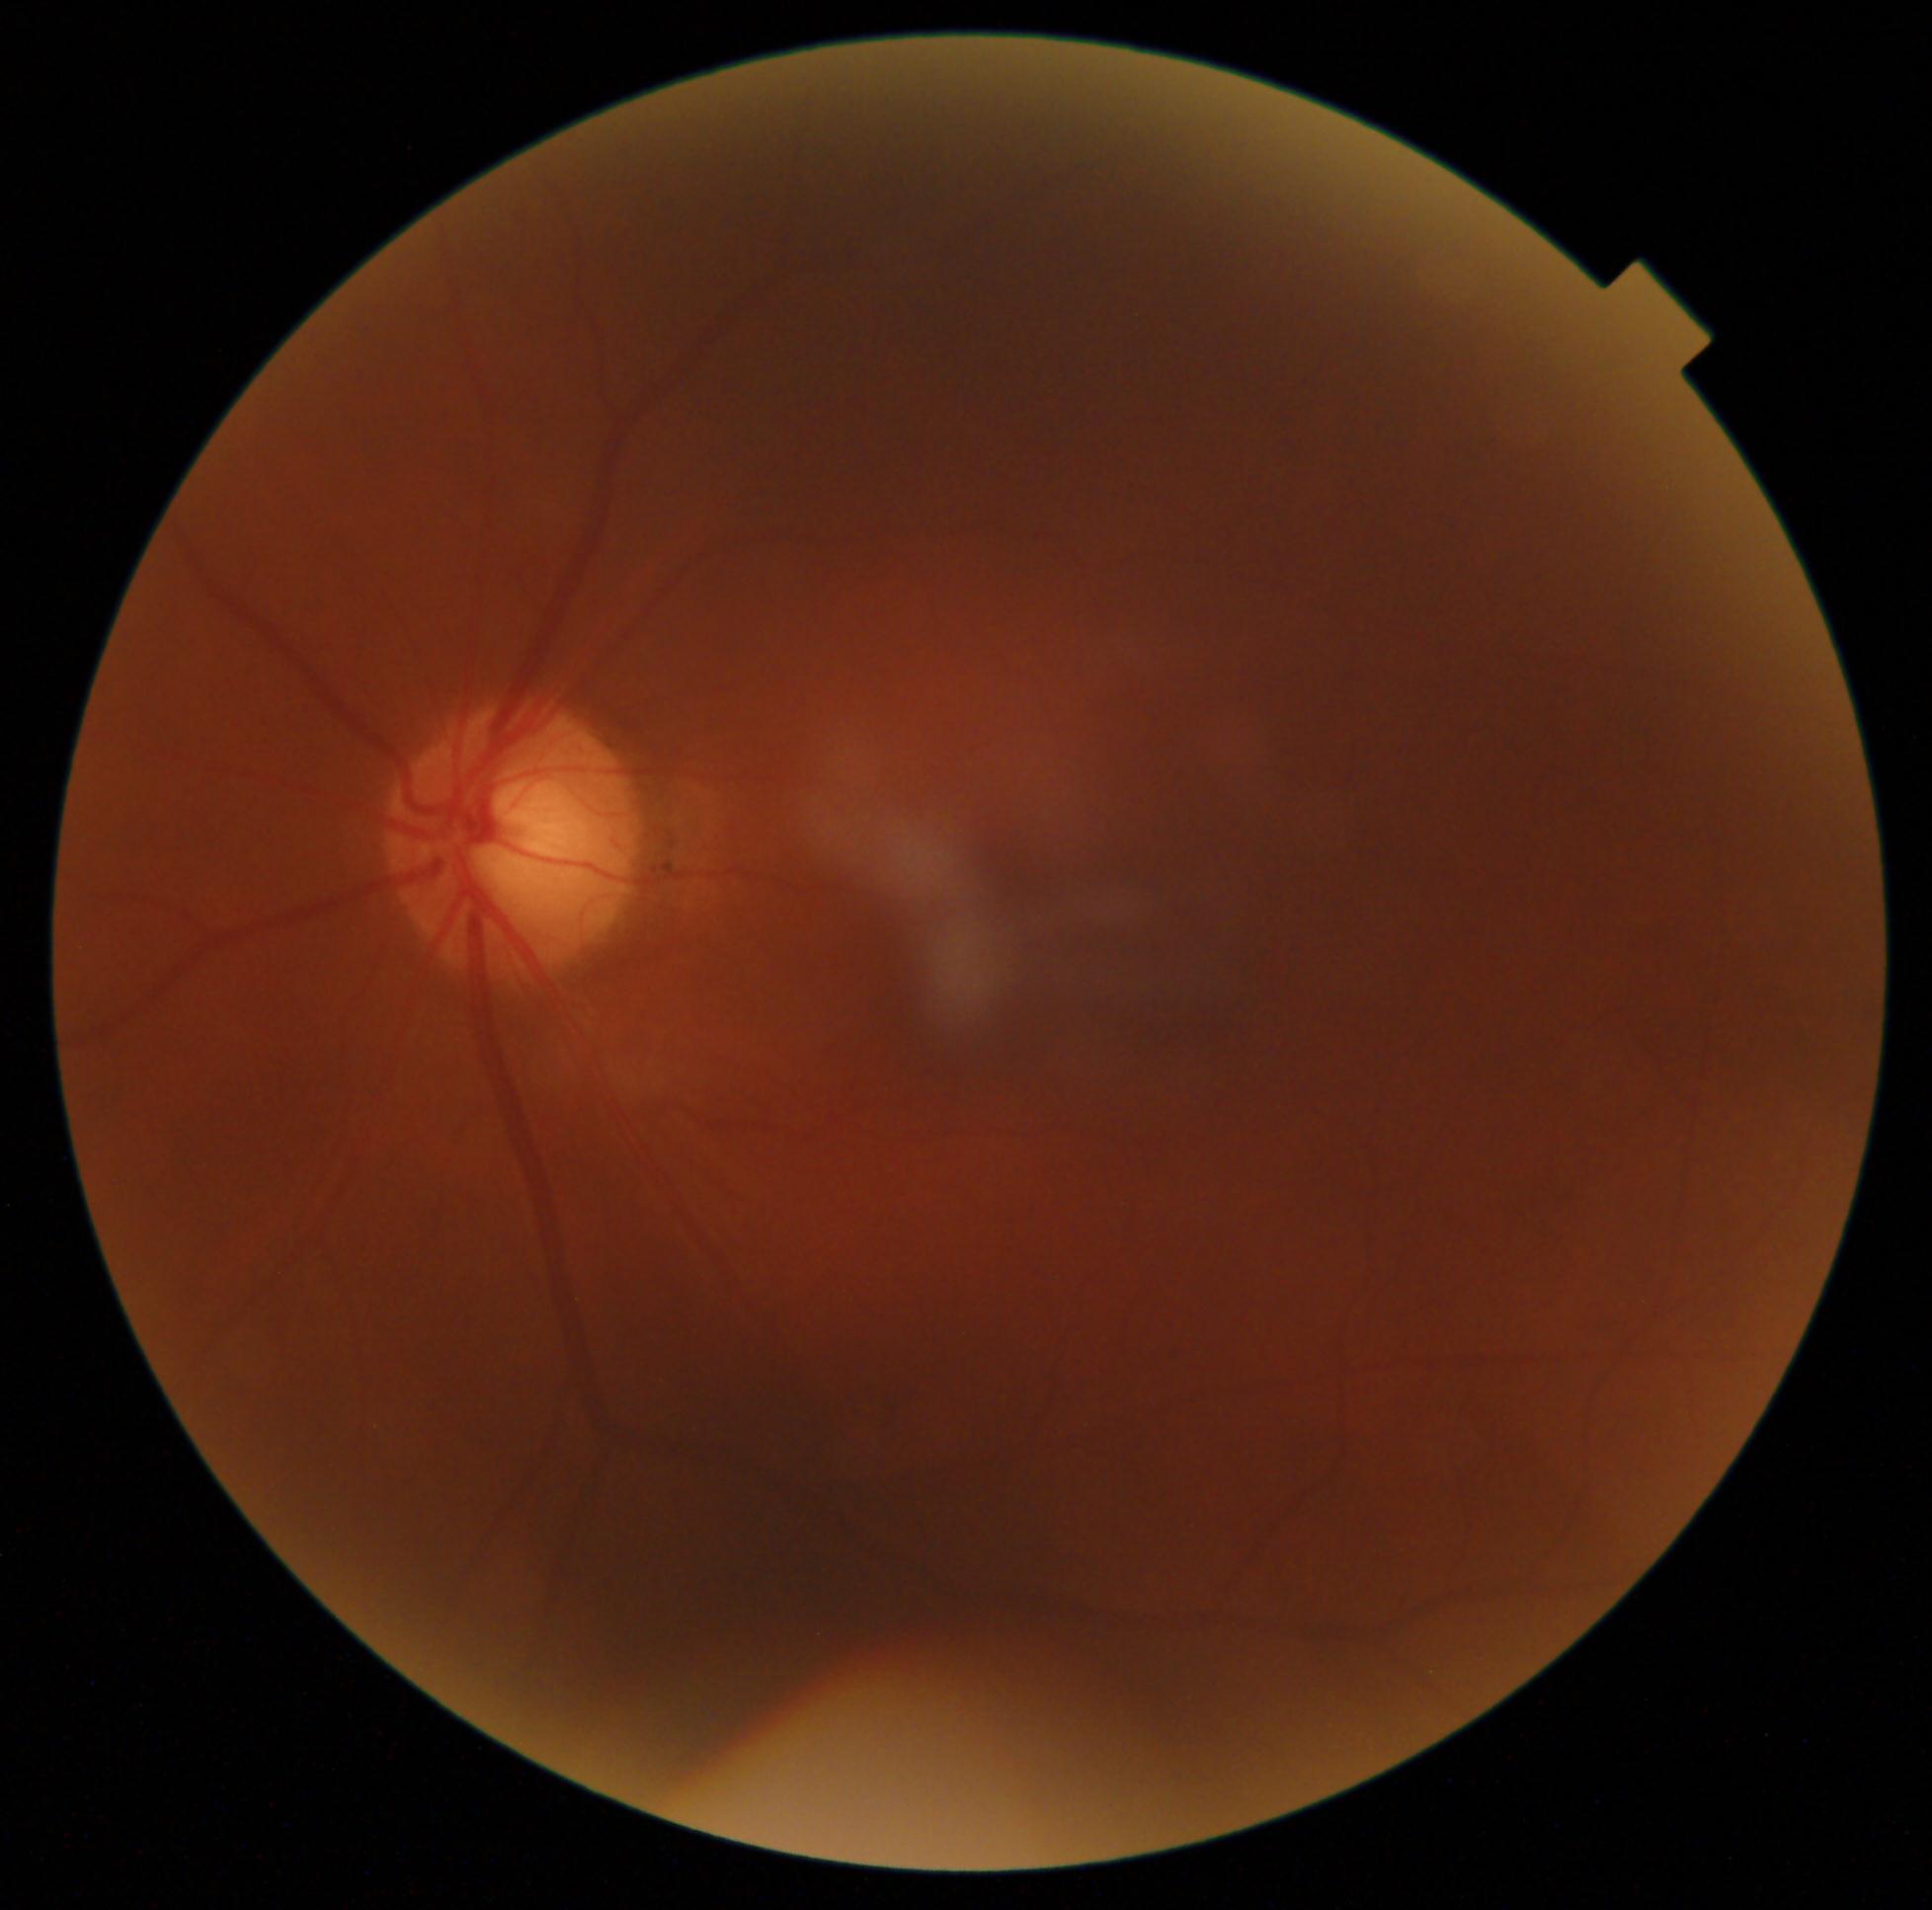 Annotations:
– DR grade: 0 (no apparent retinopathy)
– DR impression: no signs of DR